Wide-field contact fundus photograph of an infant; camera: Clarity RetCam 3 (130° FOV); 640 by 480 pixels — 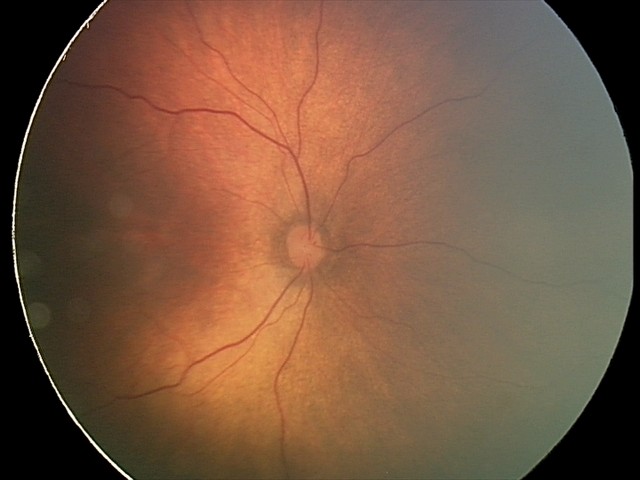

Without plus disease. Screening series with status post retinopathy of prematurity (ROP).